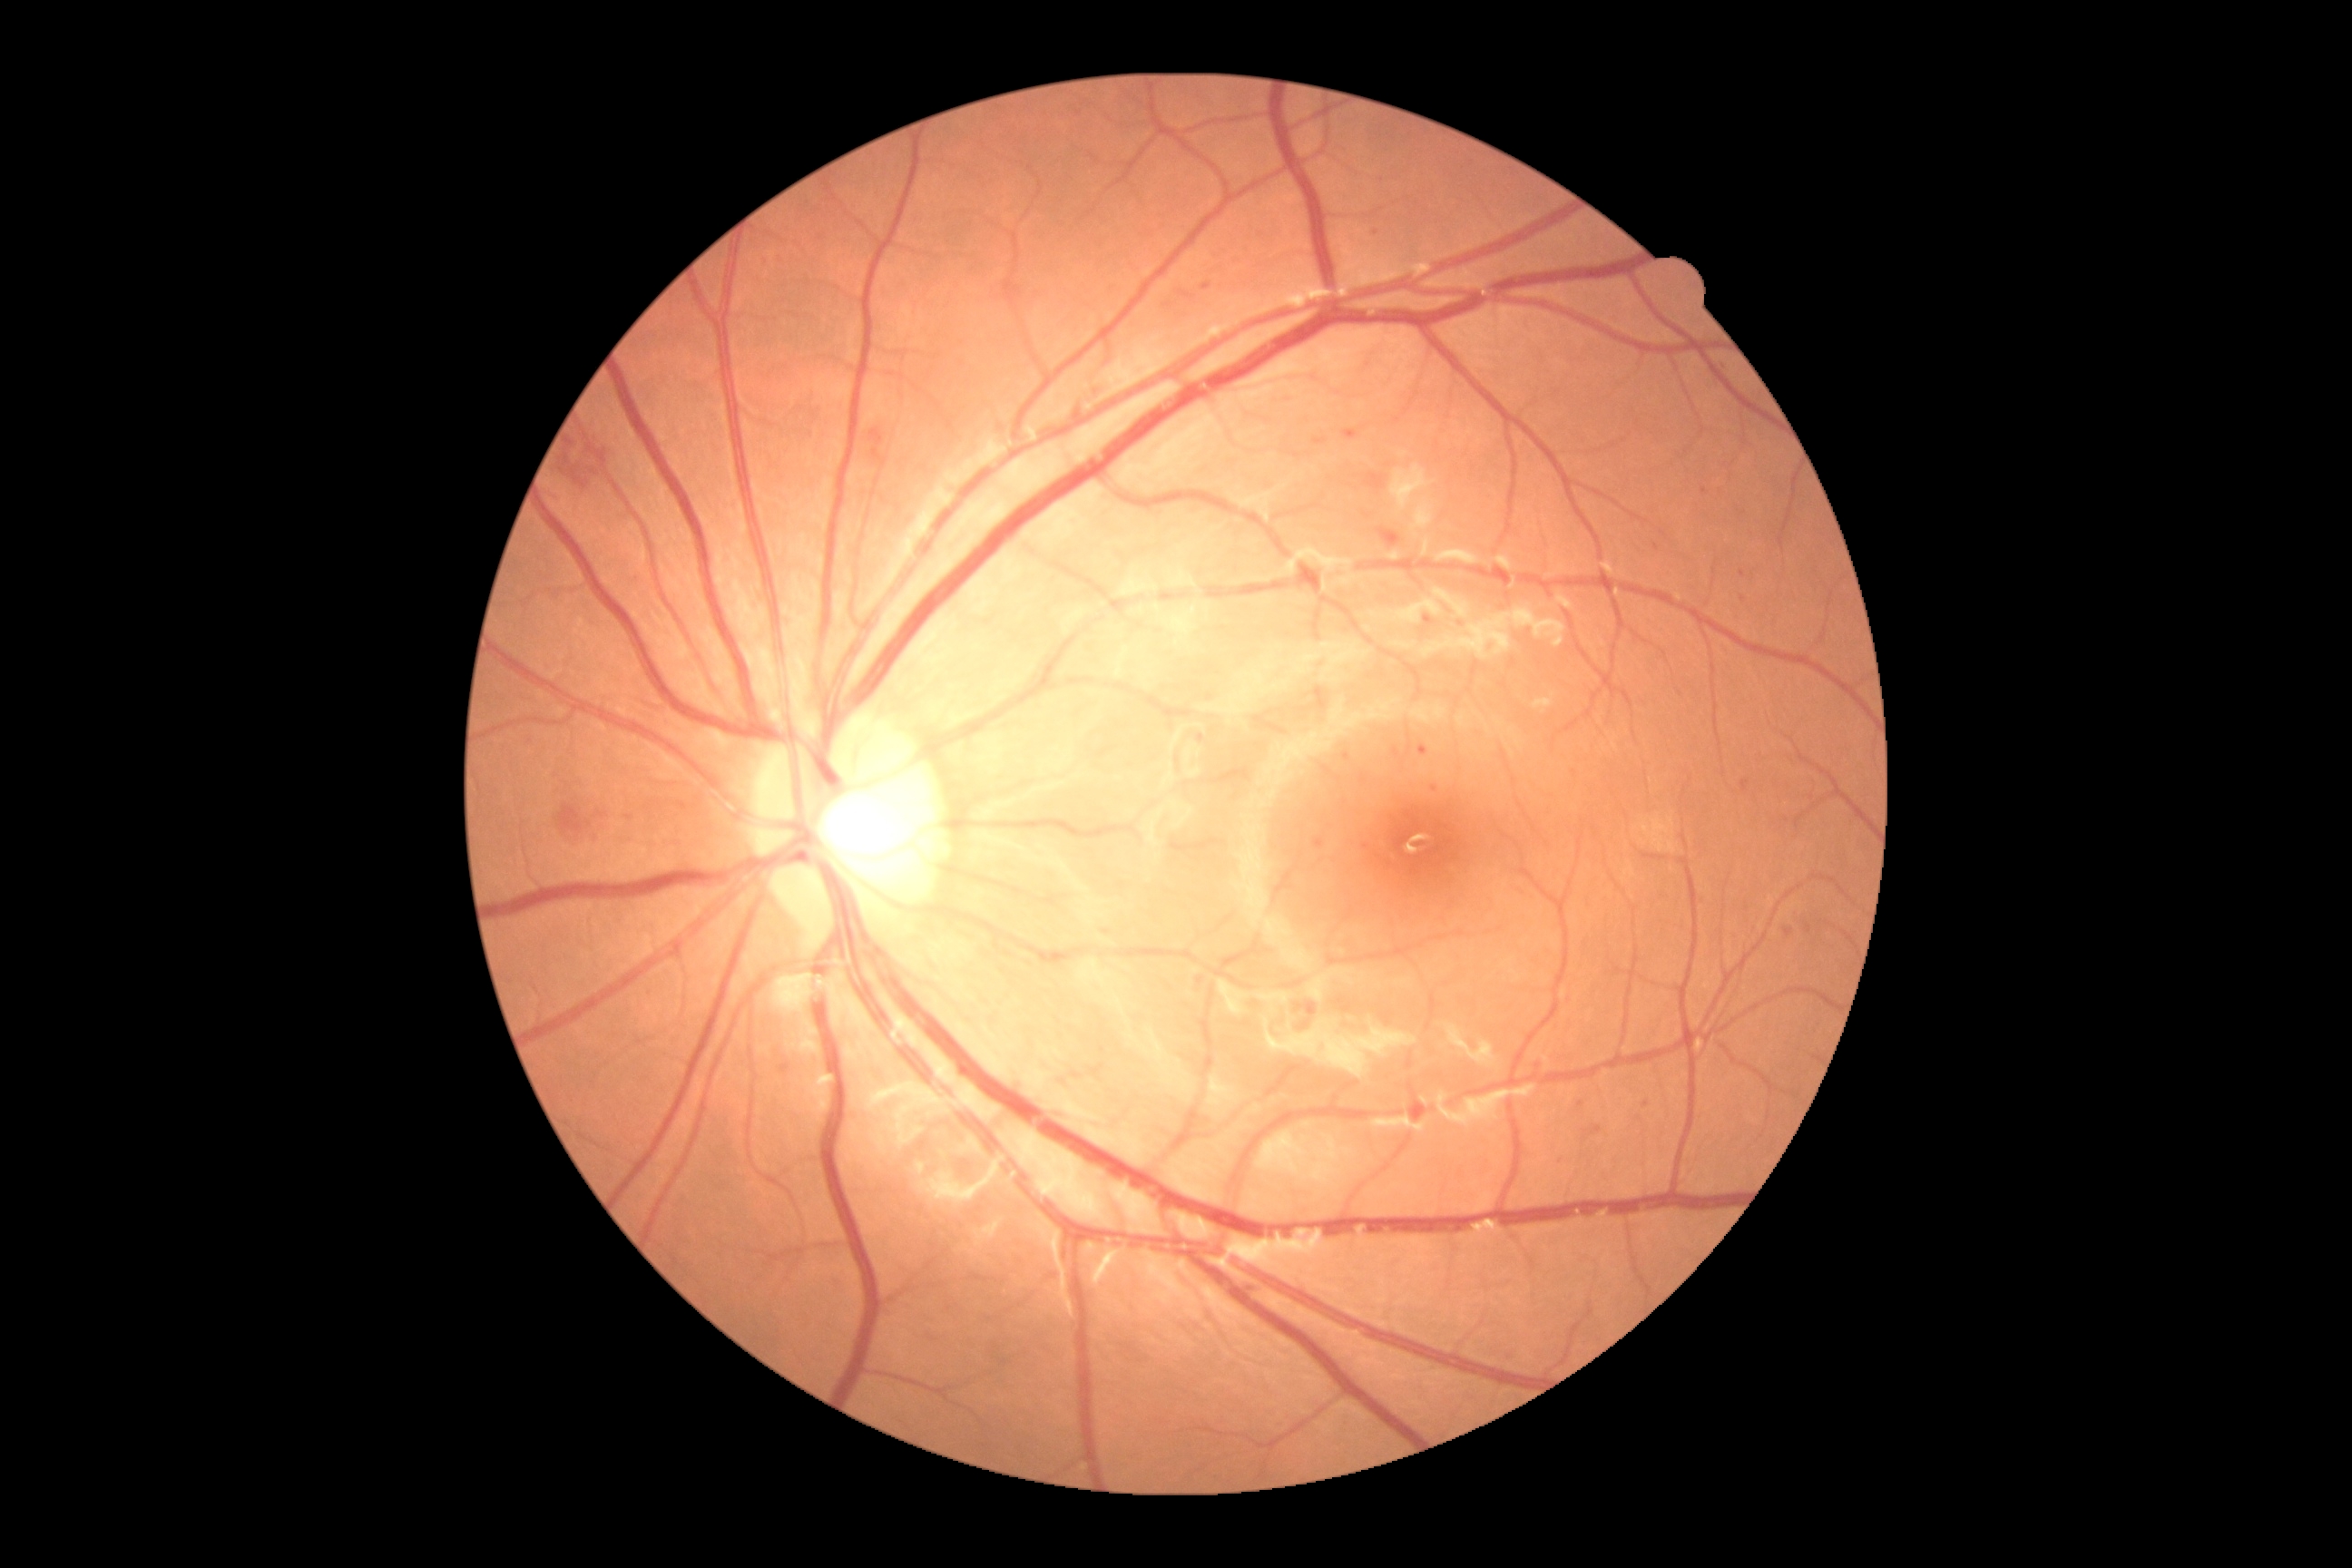

DR: moderate non-proliferative diabetic retinopathy (grade 2) — more than just microaneurysms but less than severe NPDR.